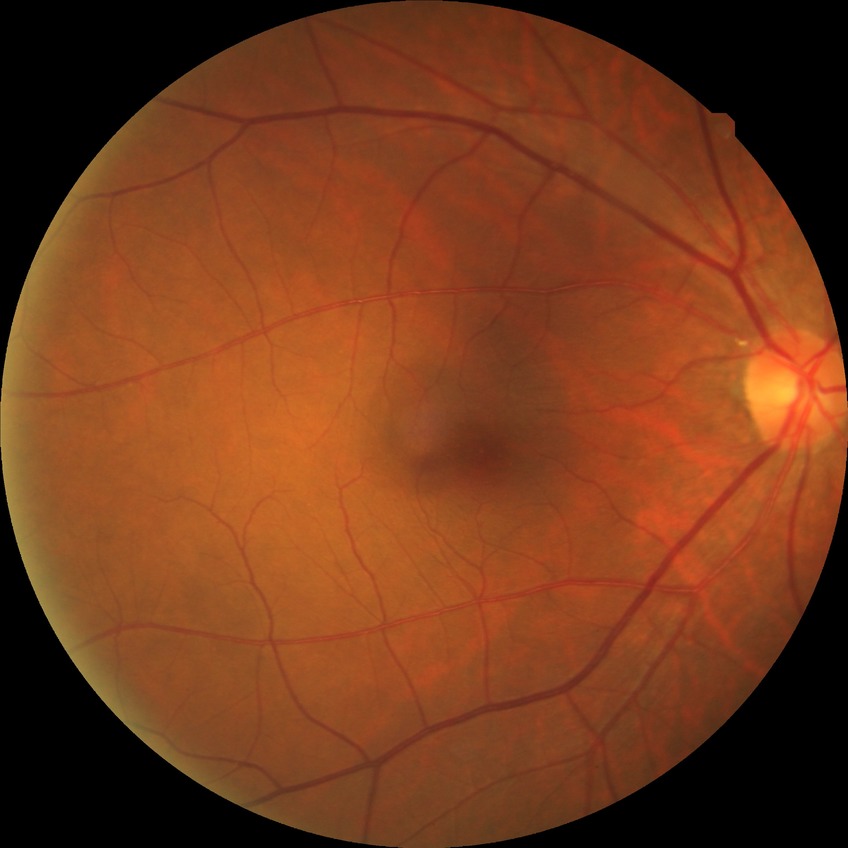
diabetic retinopathy (DR): no diabetic retinopathy (NDR).